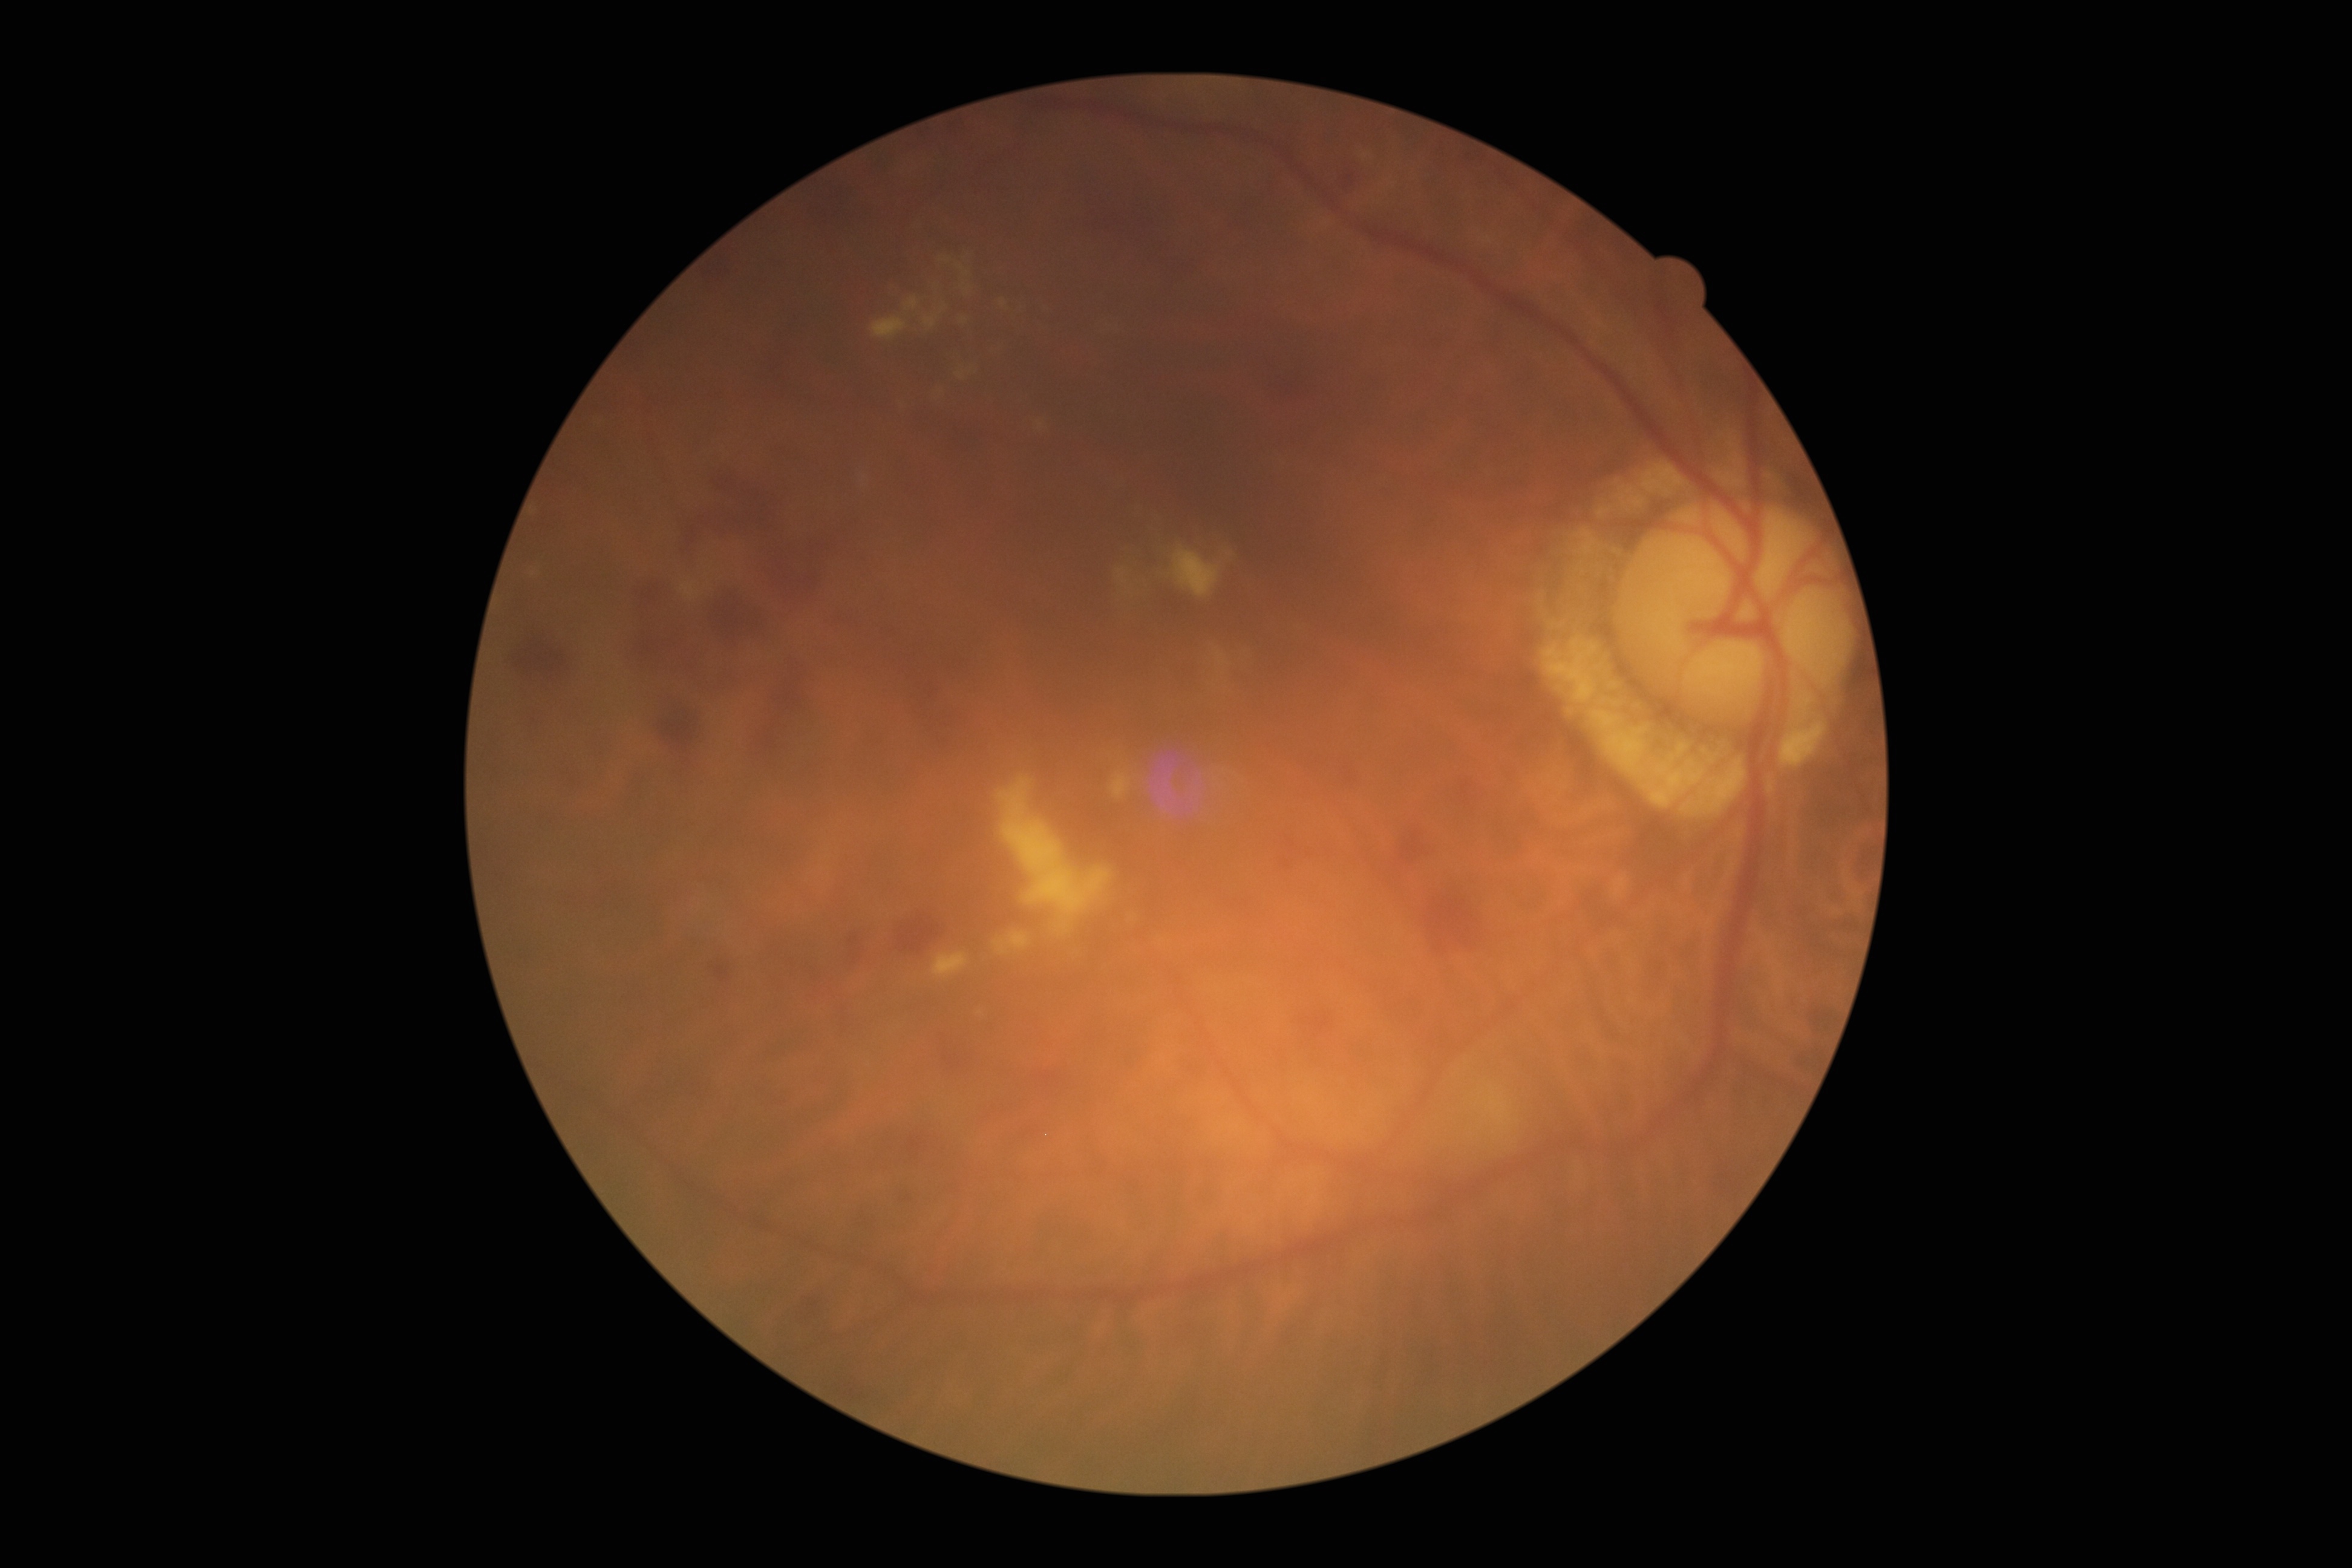

Diabetic retinopathy (DR) is moderate NPDR (grade 2) — more than just microaneurysms but less than severe NPDR.